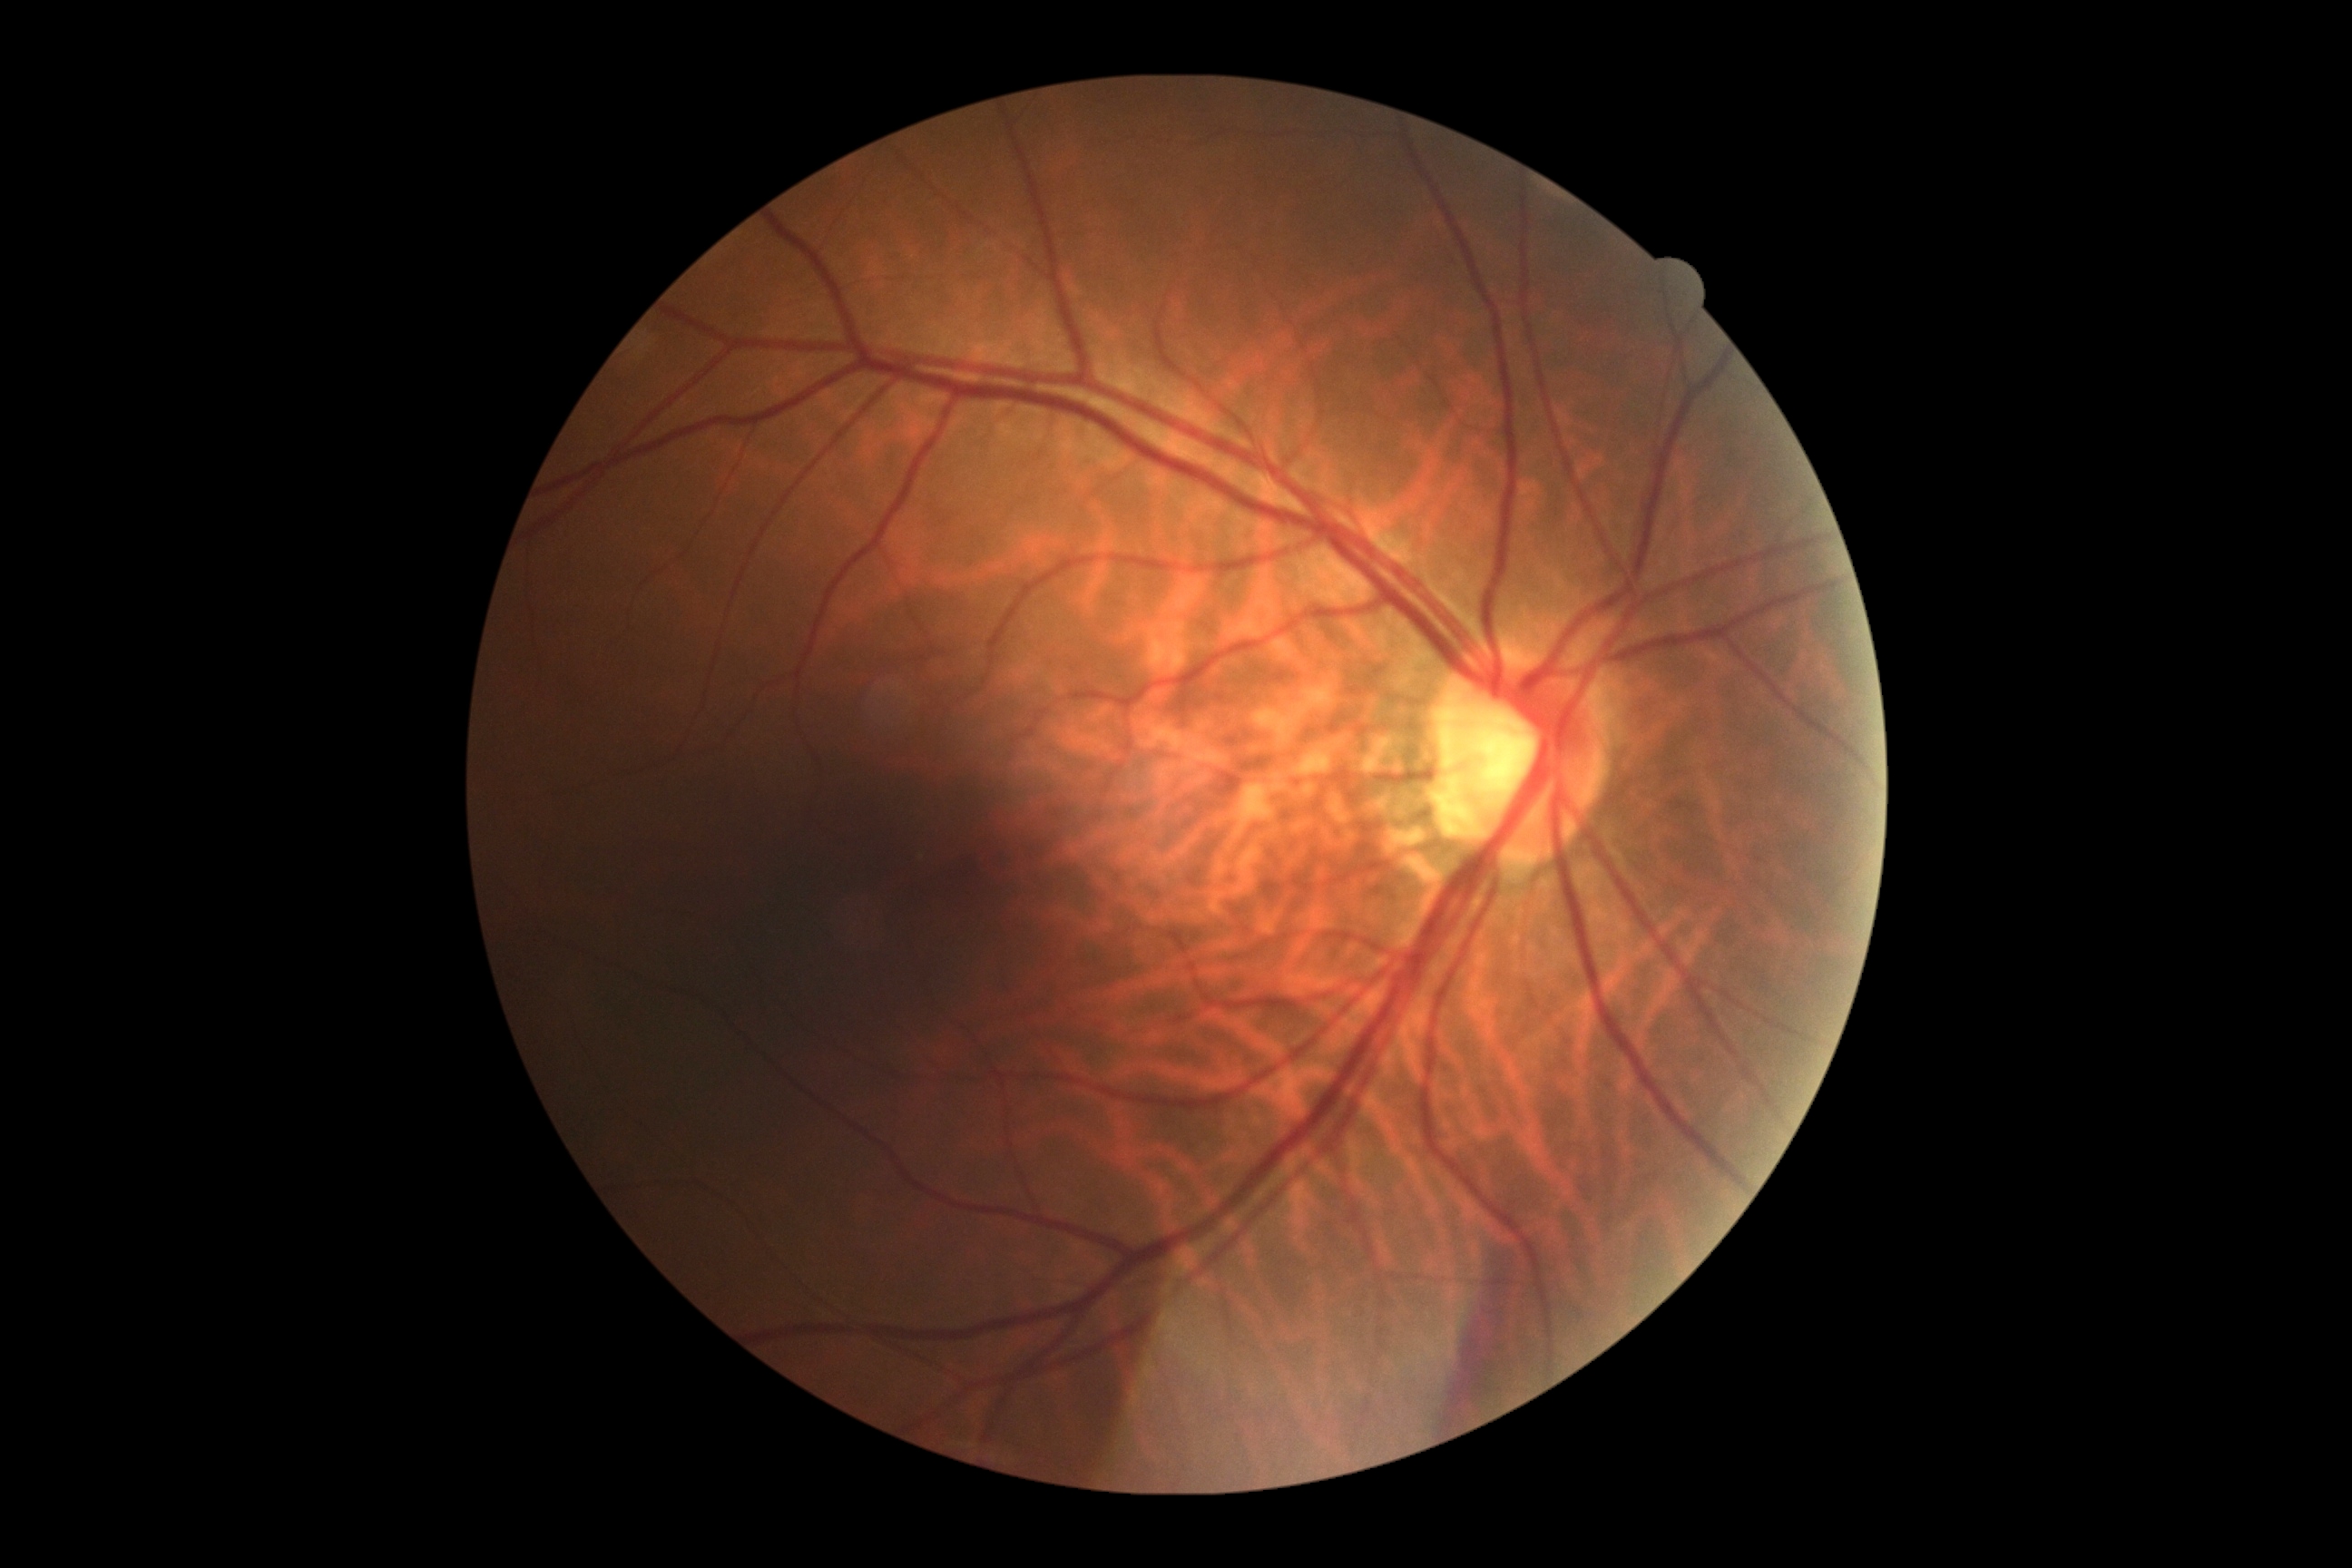

DR stage is no apparent retinopathy (grade 0). No DR findings.